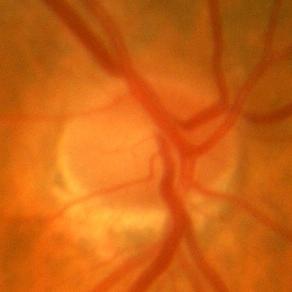
Q: Is there glaucomatous optic neuropathy?
A: No — no evidence of glaucoma.